1240 x 1240 pixels; camera: Phoenix ICON (100° FOV); Phoenix ICON wide-field infant fundus image.
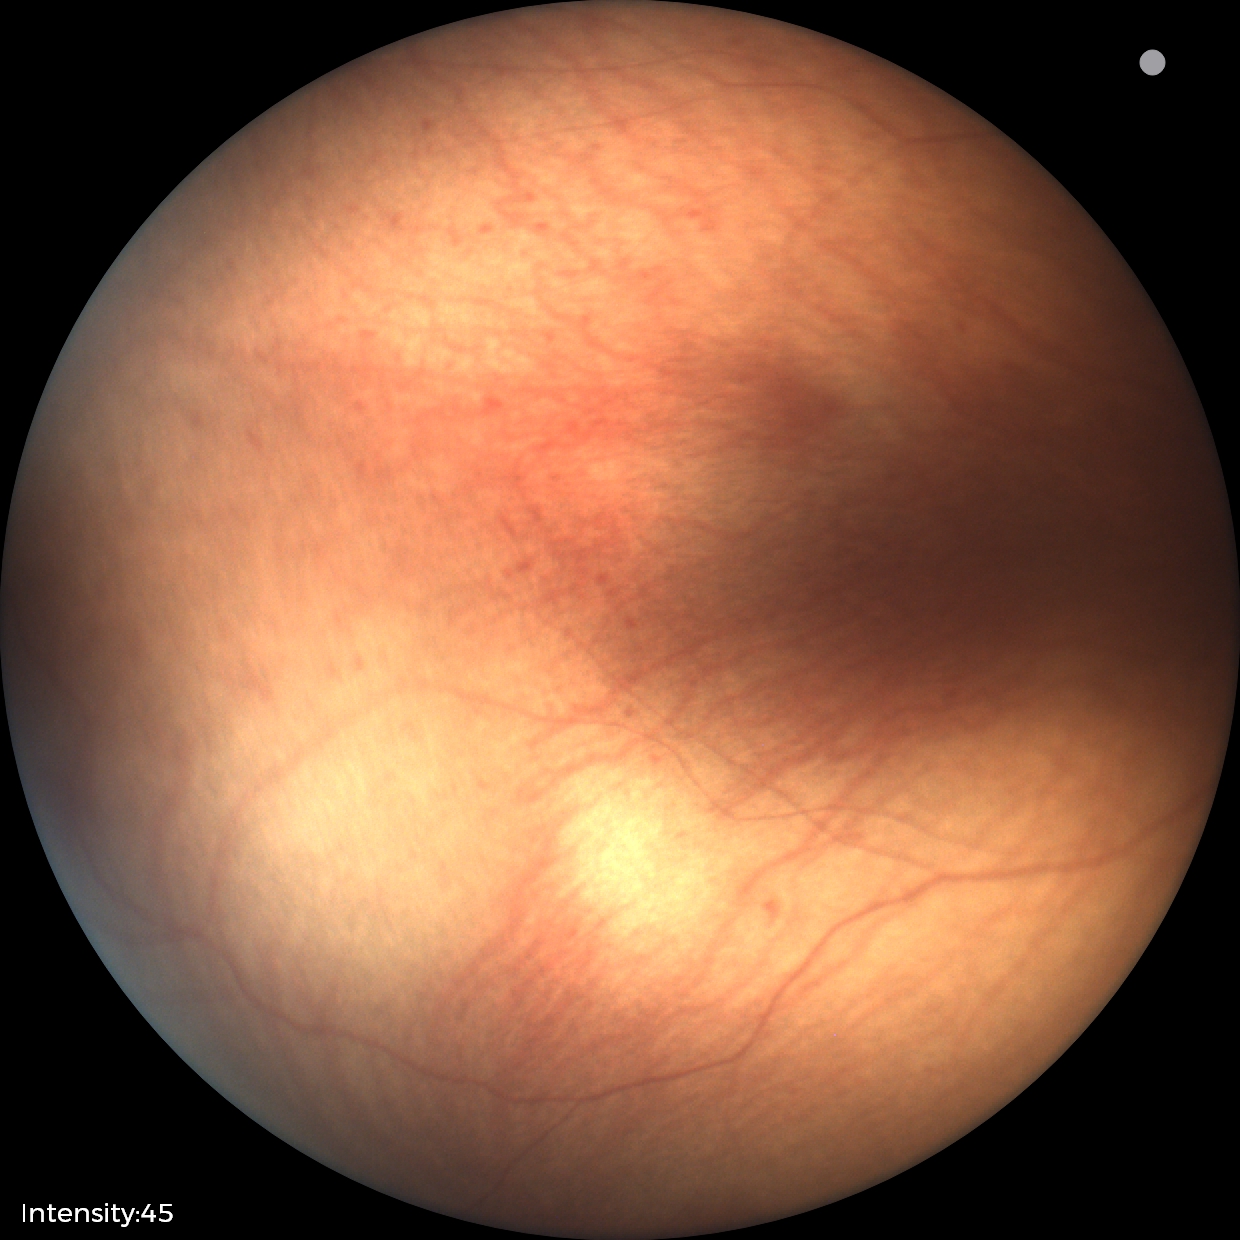 Screening examination diagnosed as physiological.